Camera: NIDEK AFC-230 · fundus photo · 848 x 848 pixels · nonmydriatic fundus photograph
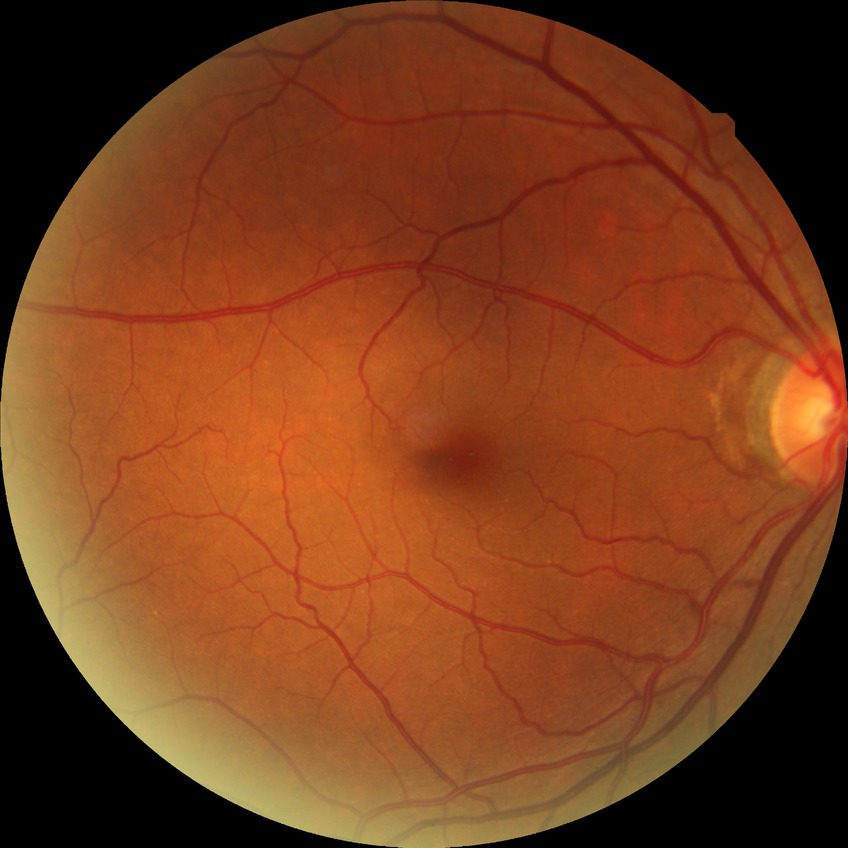
davis_grade: no diabetic retinopathy (NDR)